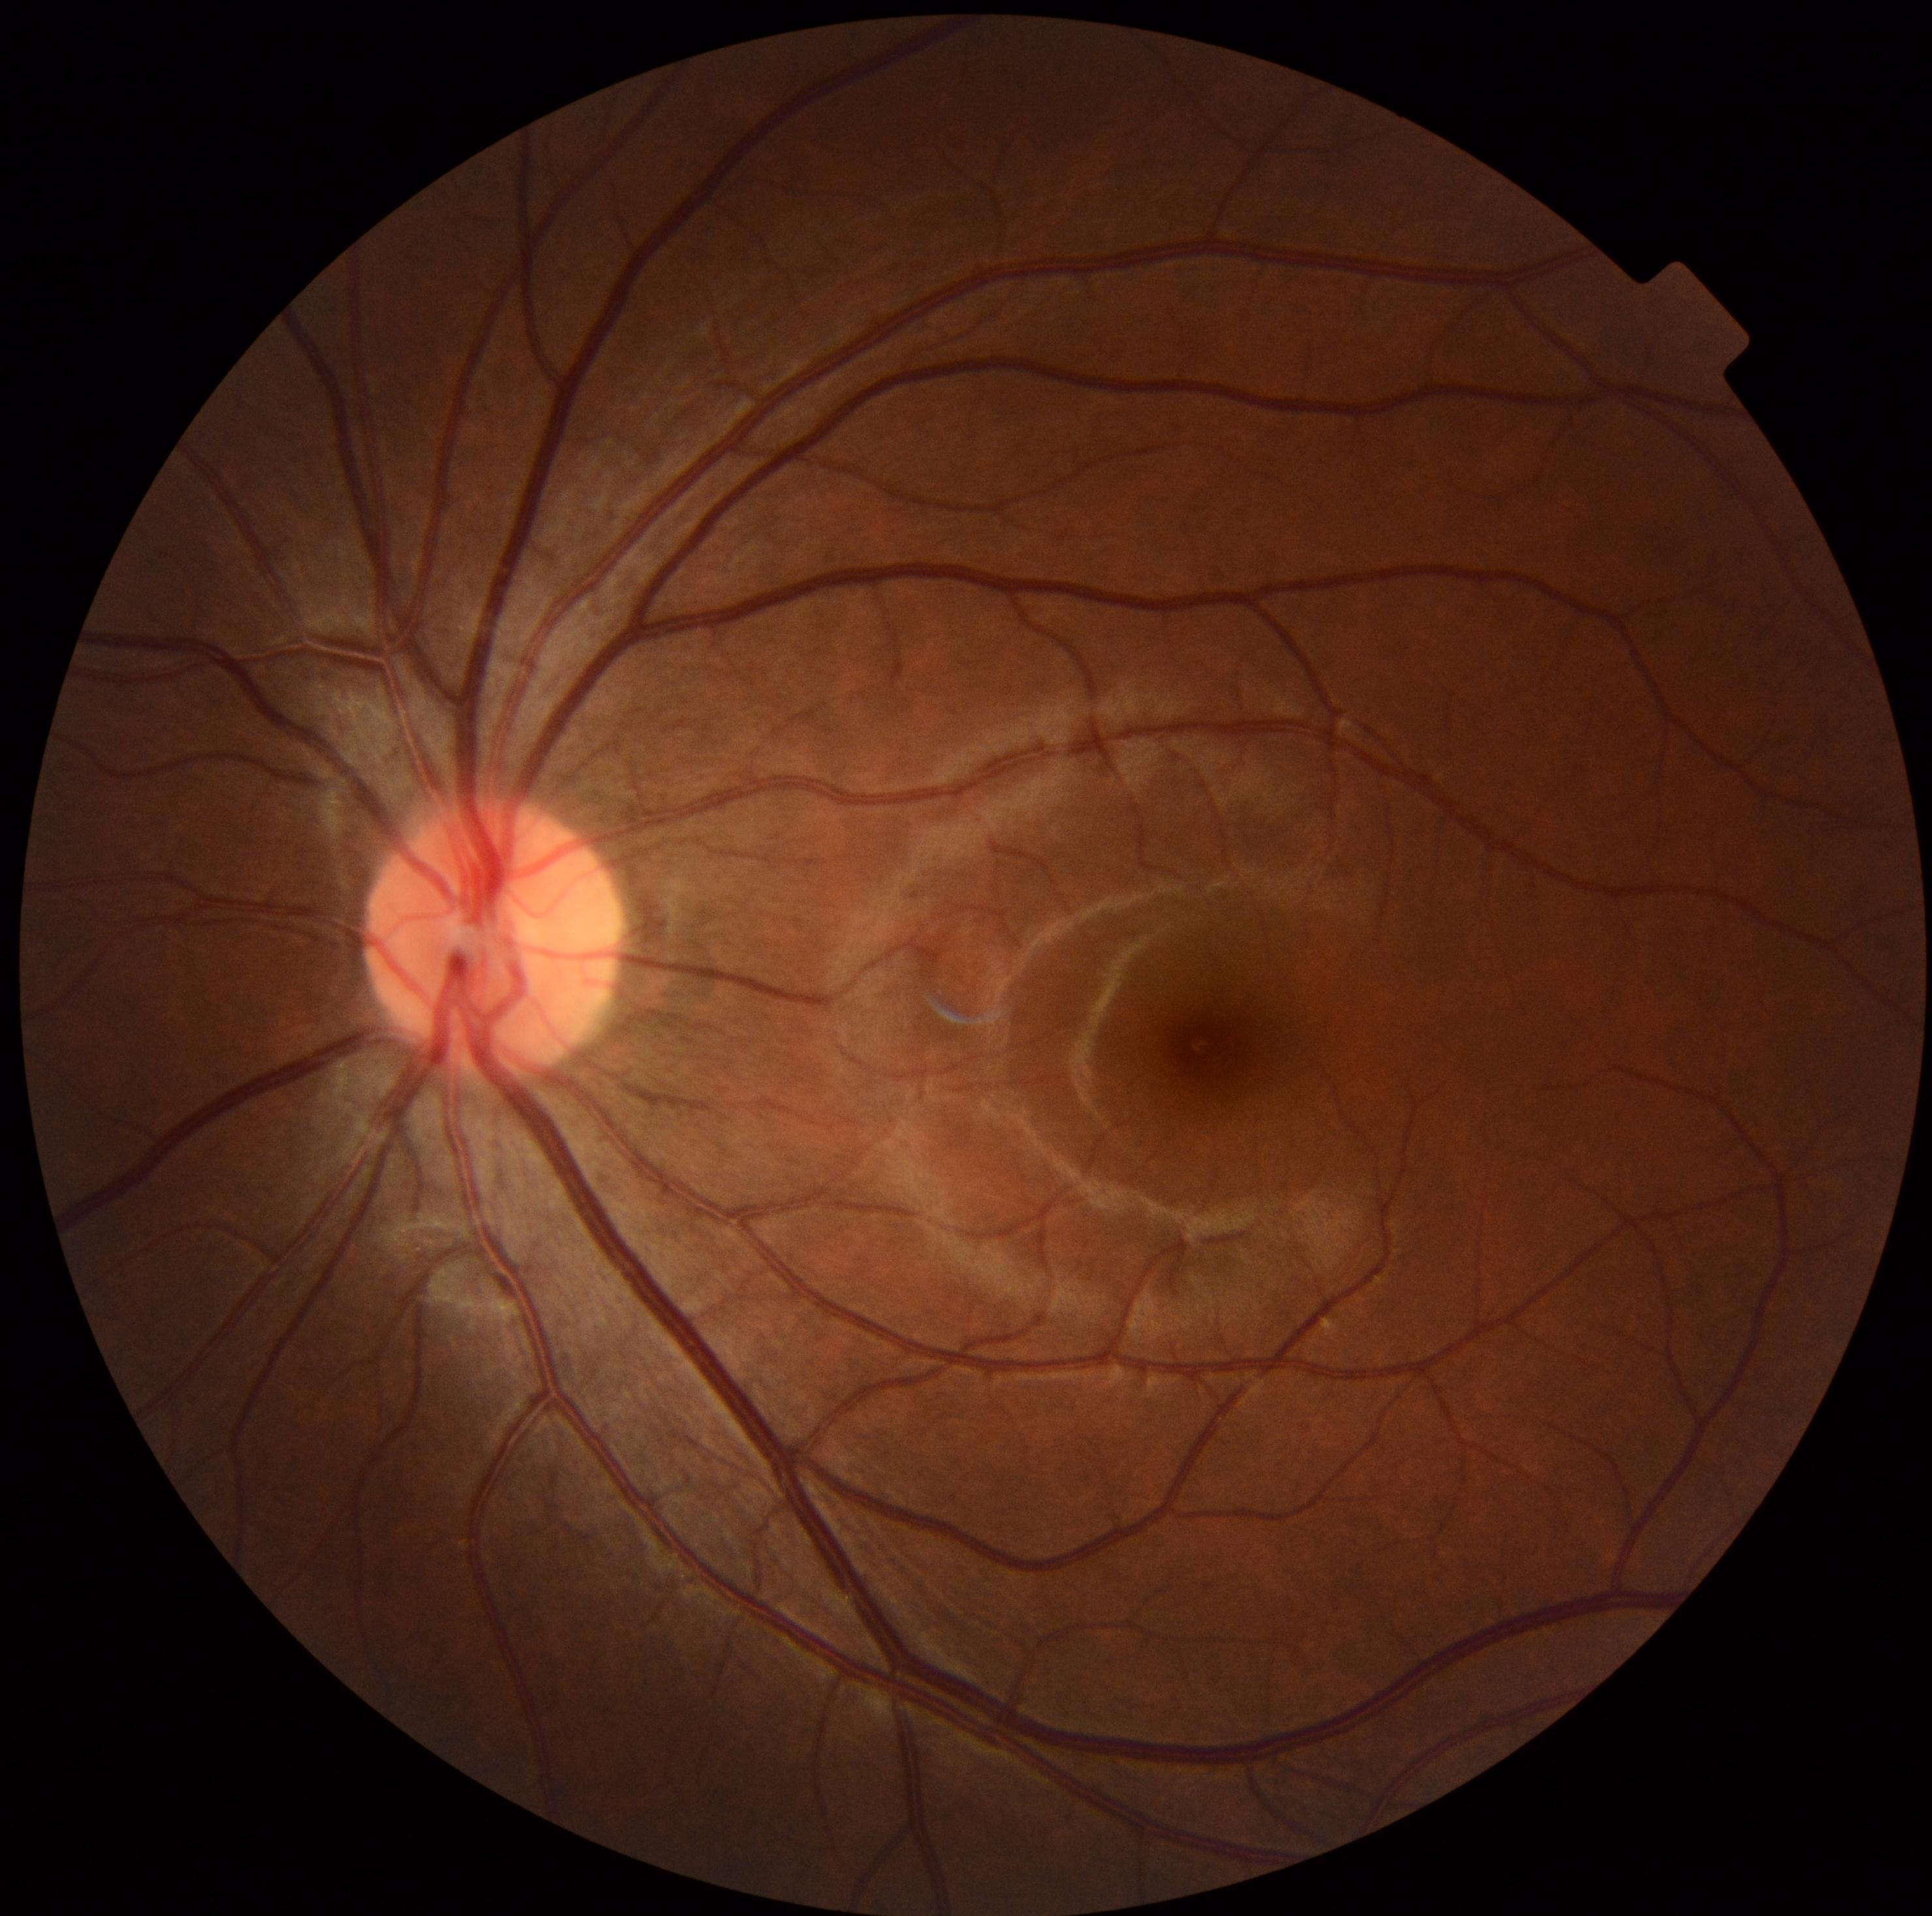
Annotations:
* diabetic retinopathy — grade 0 (no apparent retinopathy)
* DR impression — no apparent DR